RetCam wide-field infant fundus image
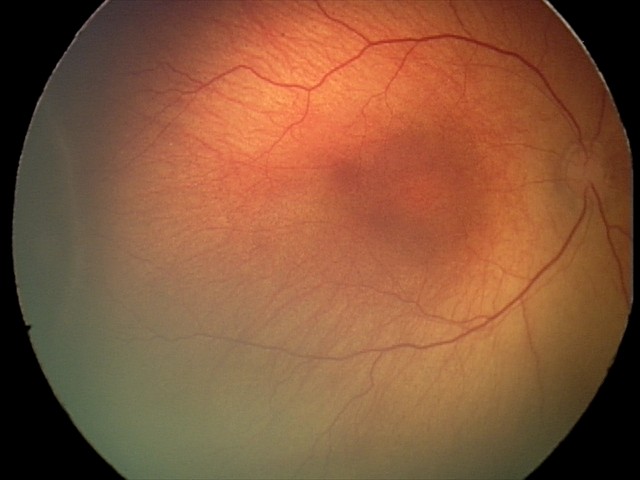

From an examination with diagnosis of ROP stage 2.